Fundus photo — 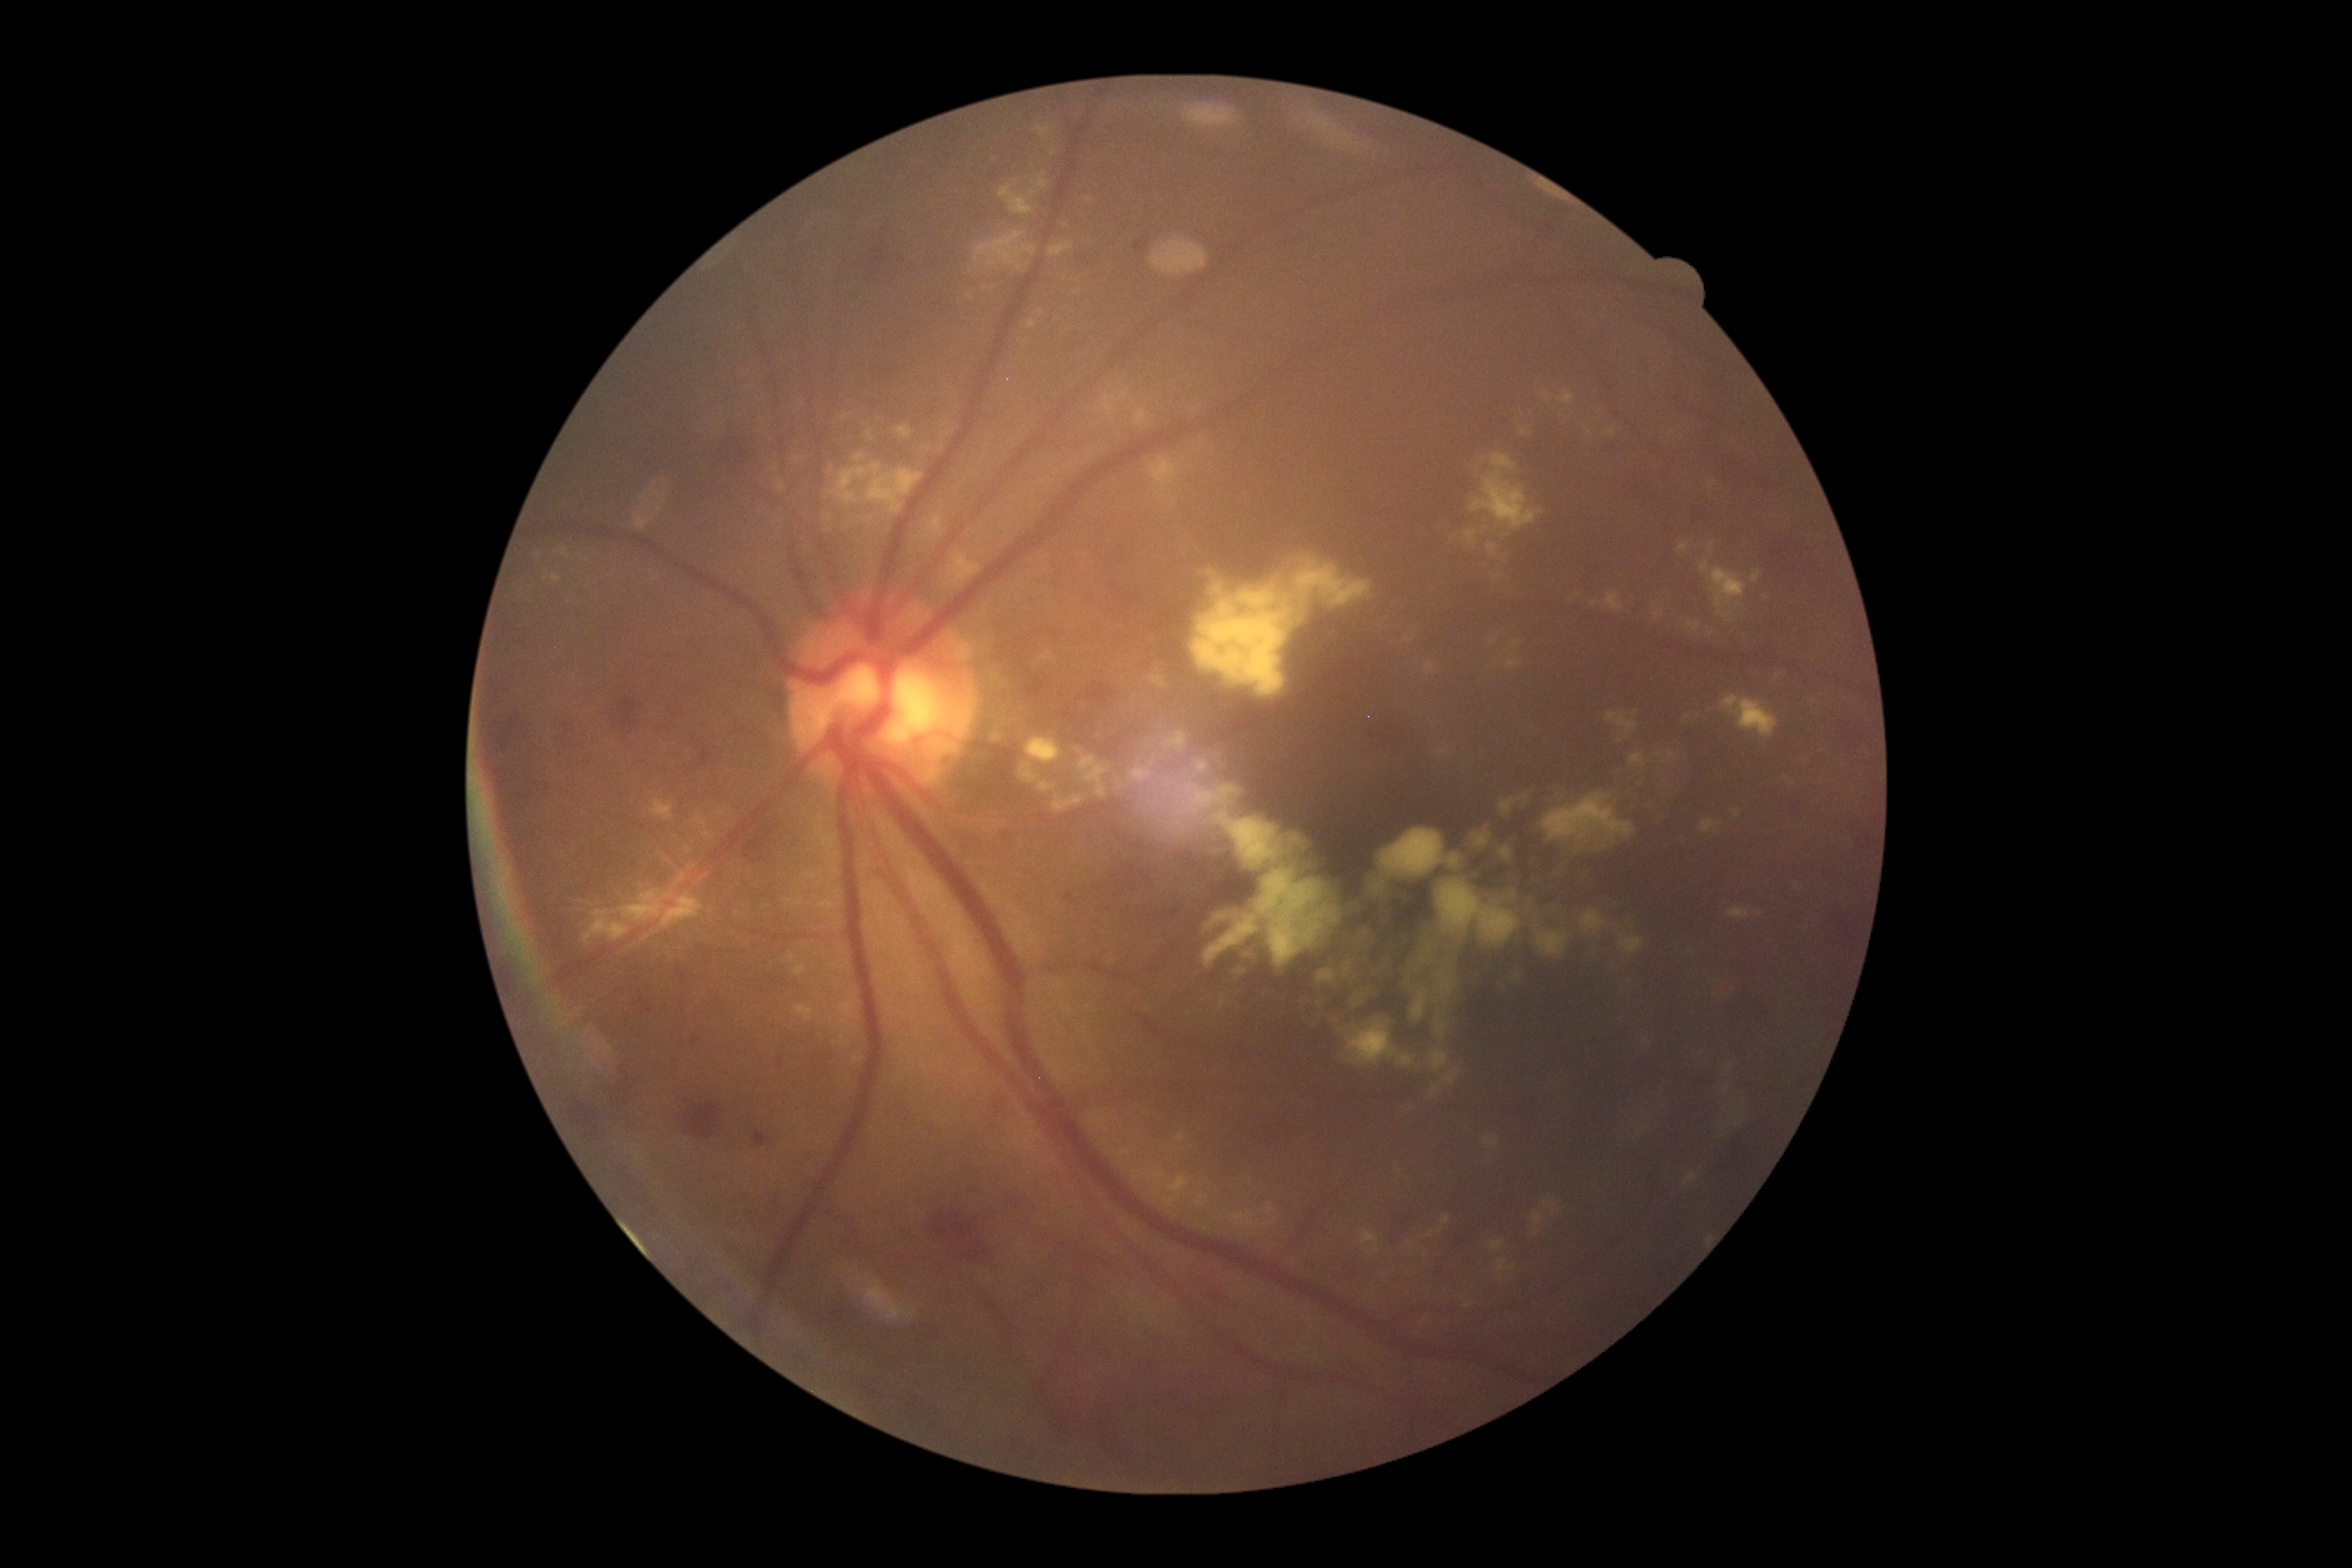 DR stage: 2/4.
EXs include those at box=[789, 954, 796, 965] | box=[696, 816, 707, 828] | box=[1476, 1230, 1522, 1282] | box=[796, 1006, 814, 1023] | box=[1039, 651, 1055, 662] | box=[571, 867, 712, 948] | box=[1133, 1171, 1144, 1184] | box=[839, 1001, 858, 1019] | box=[957, 113, 1099, 299] | box=[720, 808, 730, 818] | box=[1162, 1177, 1191, 1210] | box=[1465, 1300, 1475, 1308] | box=[990, 665, 1830, 1132].
Small EXs near 689/851 | 538/556.
No MAs identified.
No SEs identified.
HEs include those at box=[1061, 890, 1084, 910] | box=[1612, 478, 1674, 516] | box=[1769, 531, 1843, 587] | box=[1701, 1124, 1745, 1193] | box=[1819, 906, 1859, 959] | box=[1024, 674, 1059, 705] | box=[1825, 712, 1865, 758] | box=[1039, 1378, 1141, 1473] | box=[914, 1320, 946, 1346] | box=[683, 1102, 725, 1139] | box=[692, 1039, 700, 1048] | box=[662, 701, 683, 734] | box=[1705, 371, 1740, 409] | box=[554, 718, 585, 758] | box=[1130, 1010, 1188, 1054] | box=[1342, 709, 1429, 763] | box=[1714, 456, 1798, 507] | box=[848, 215, 934, 291] | box=[636, 999, 652, 1014].